2352x1568px; retinal fundus photograph — 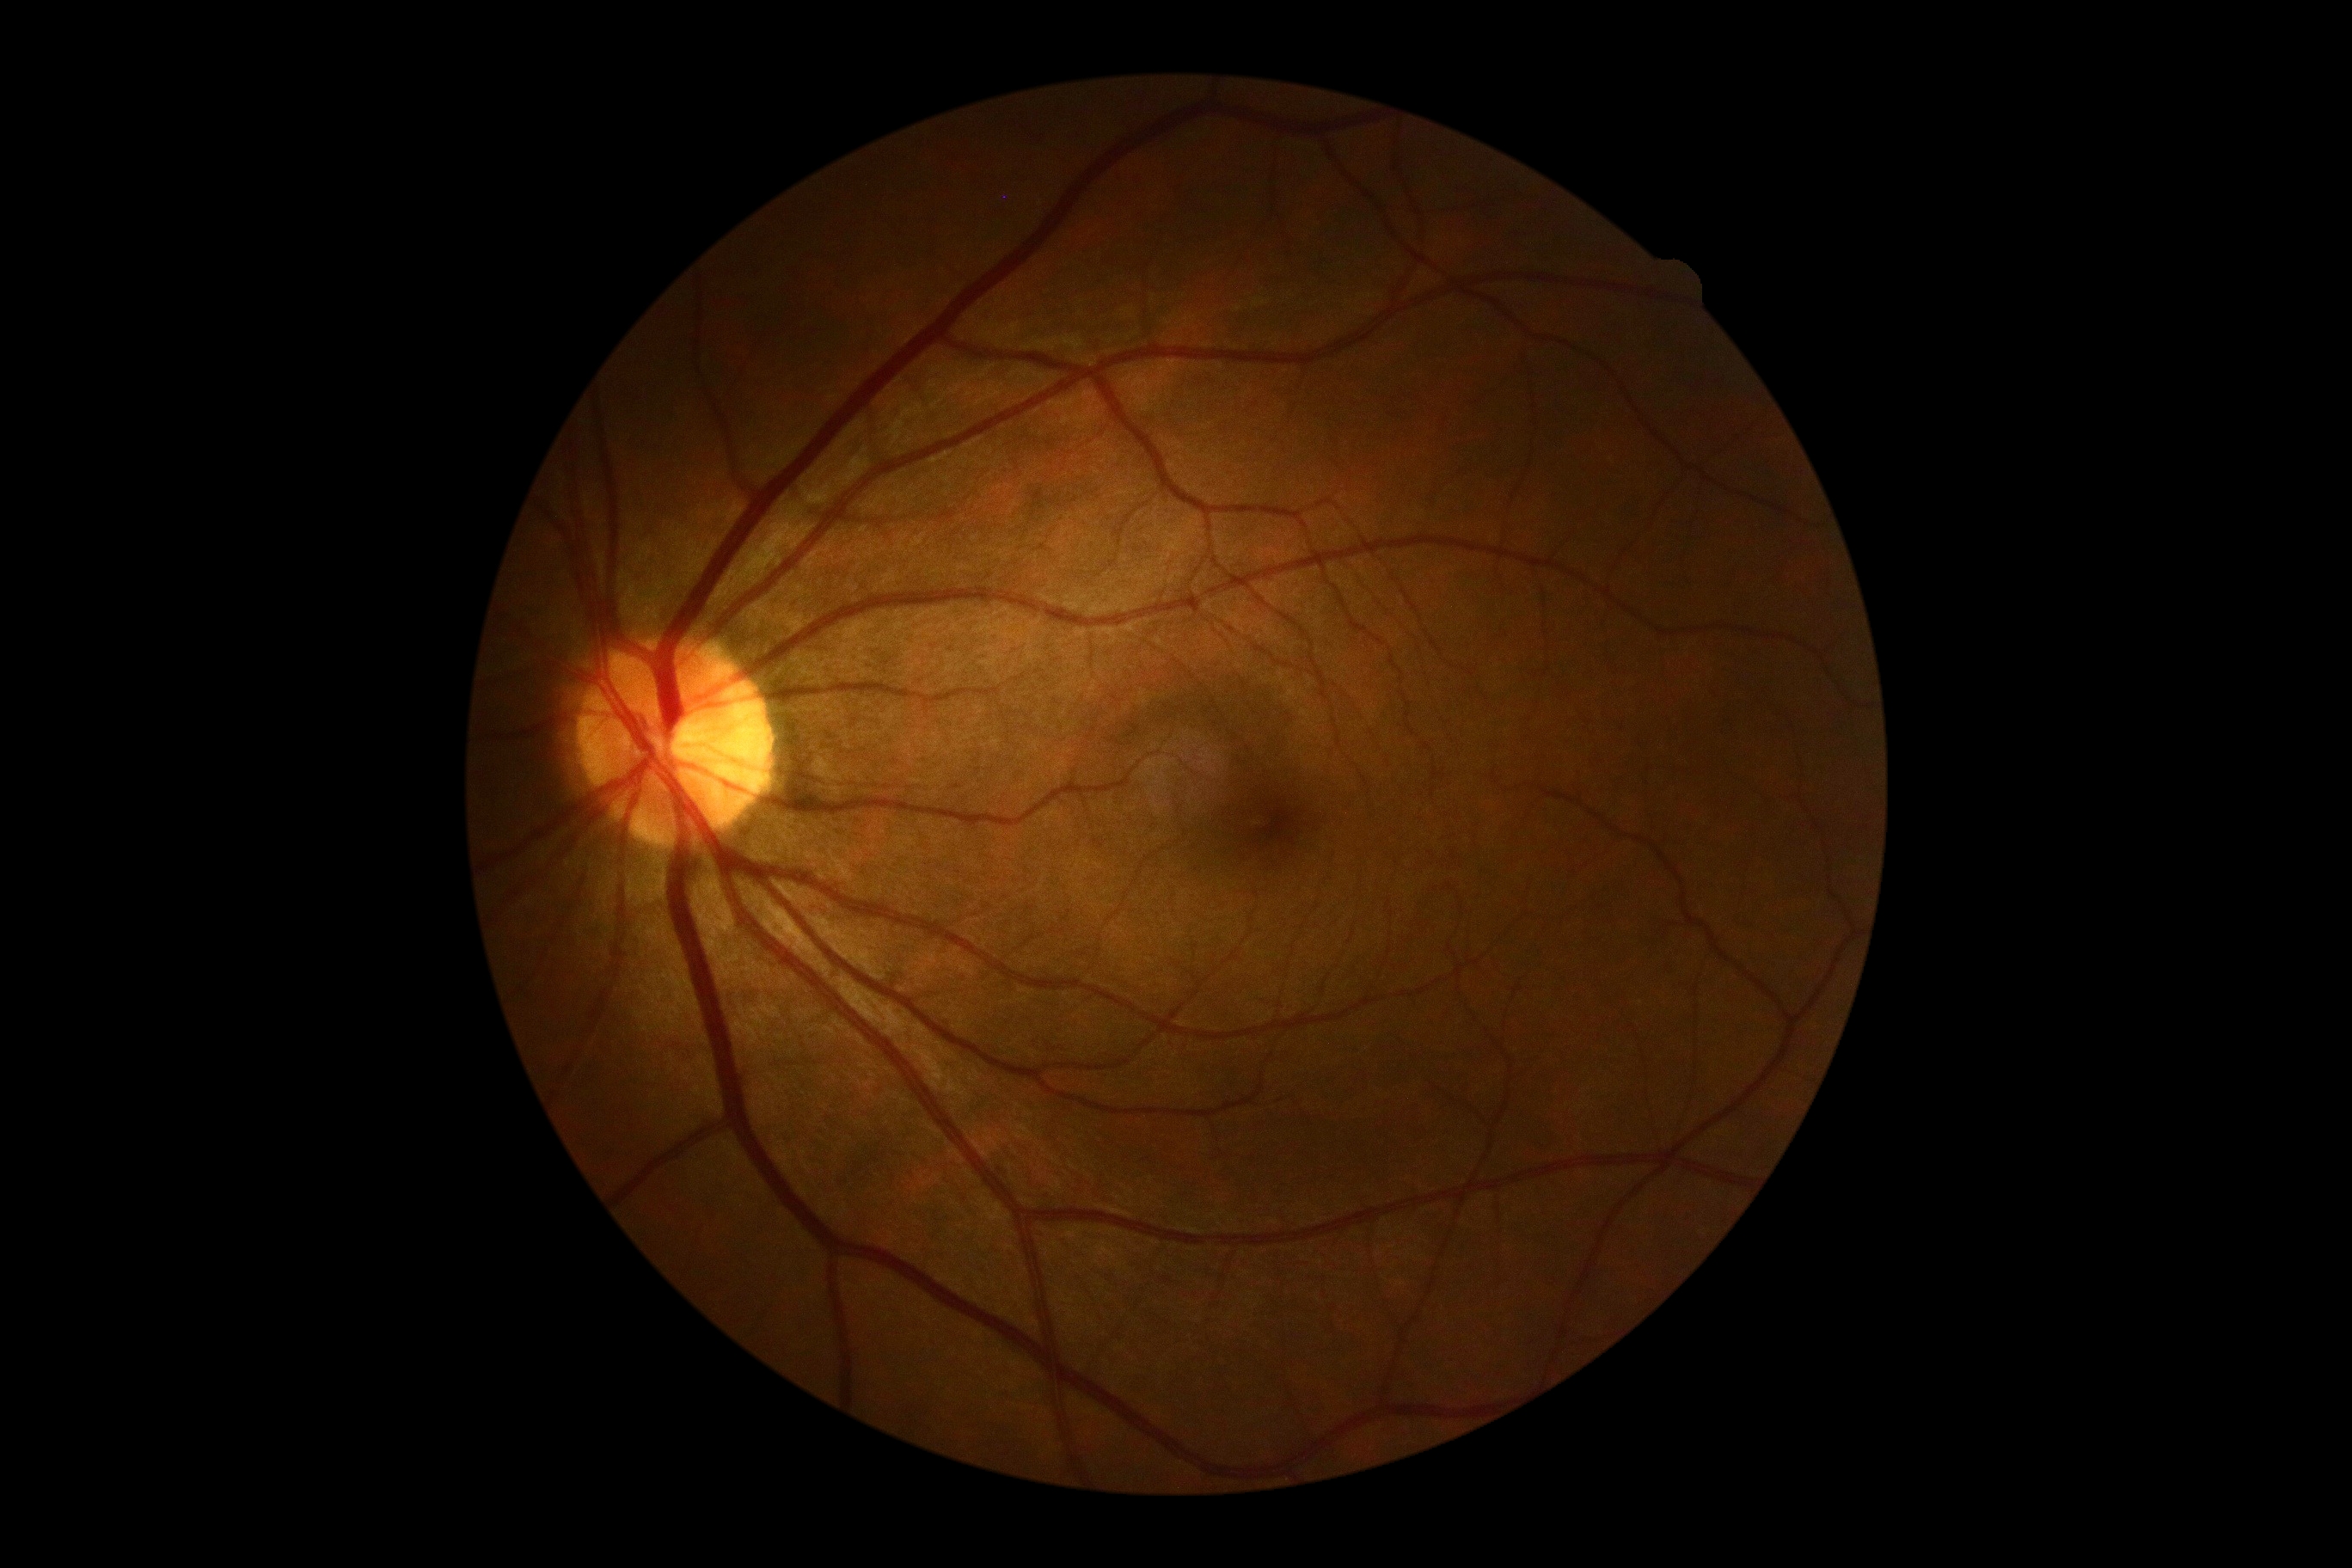

DR severity: grade 0 (no apparent retinopathy).